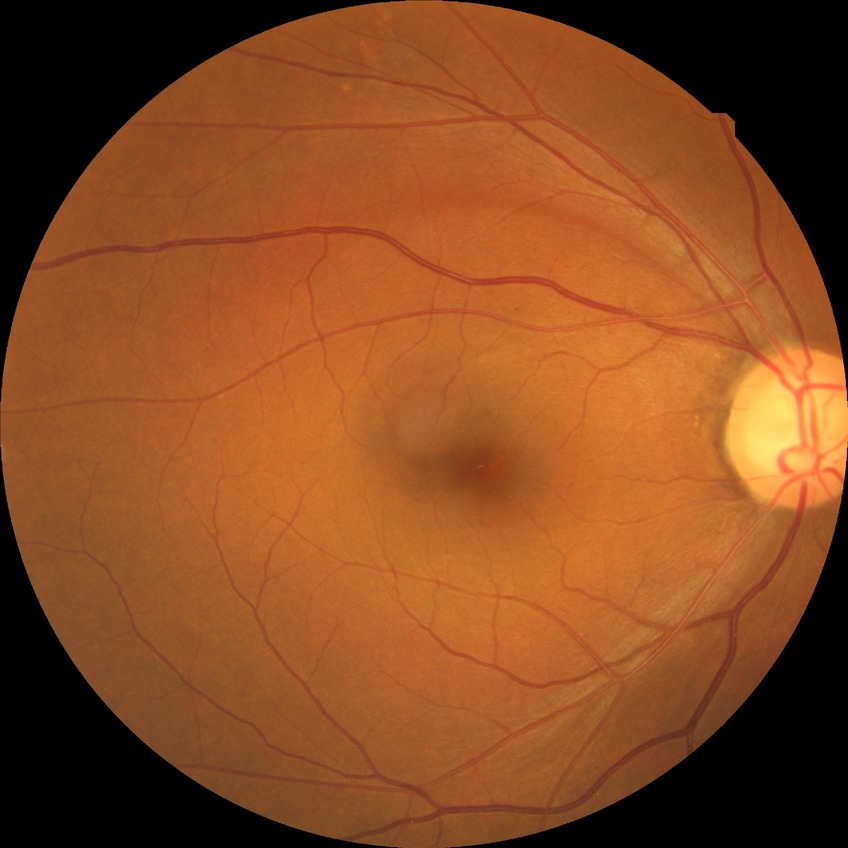 Diabetic retinopathy grade: no diabetic retinopathy.